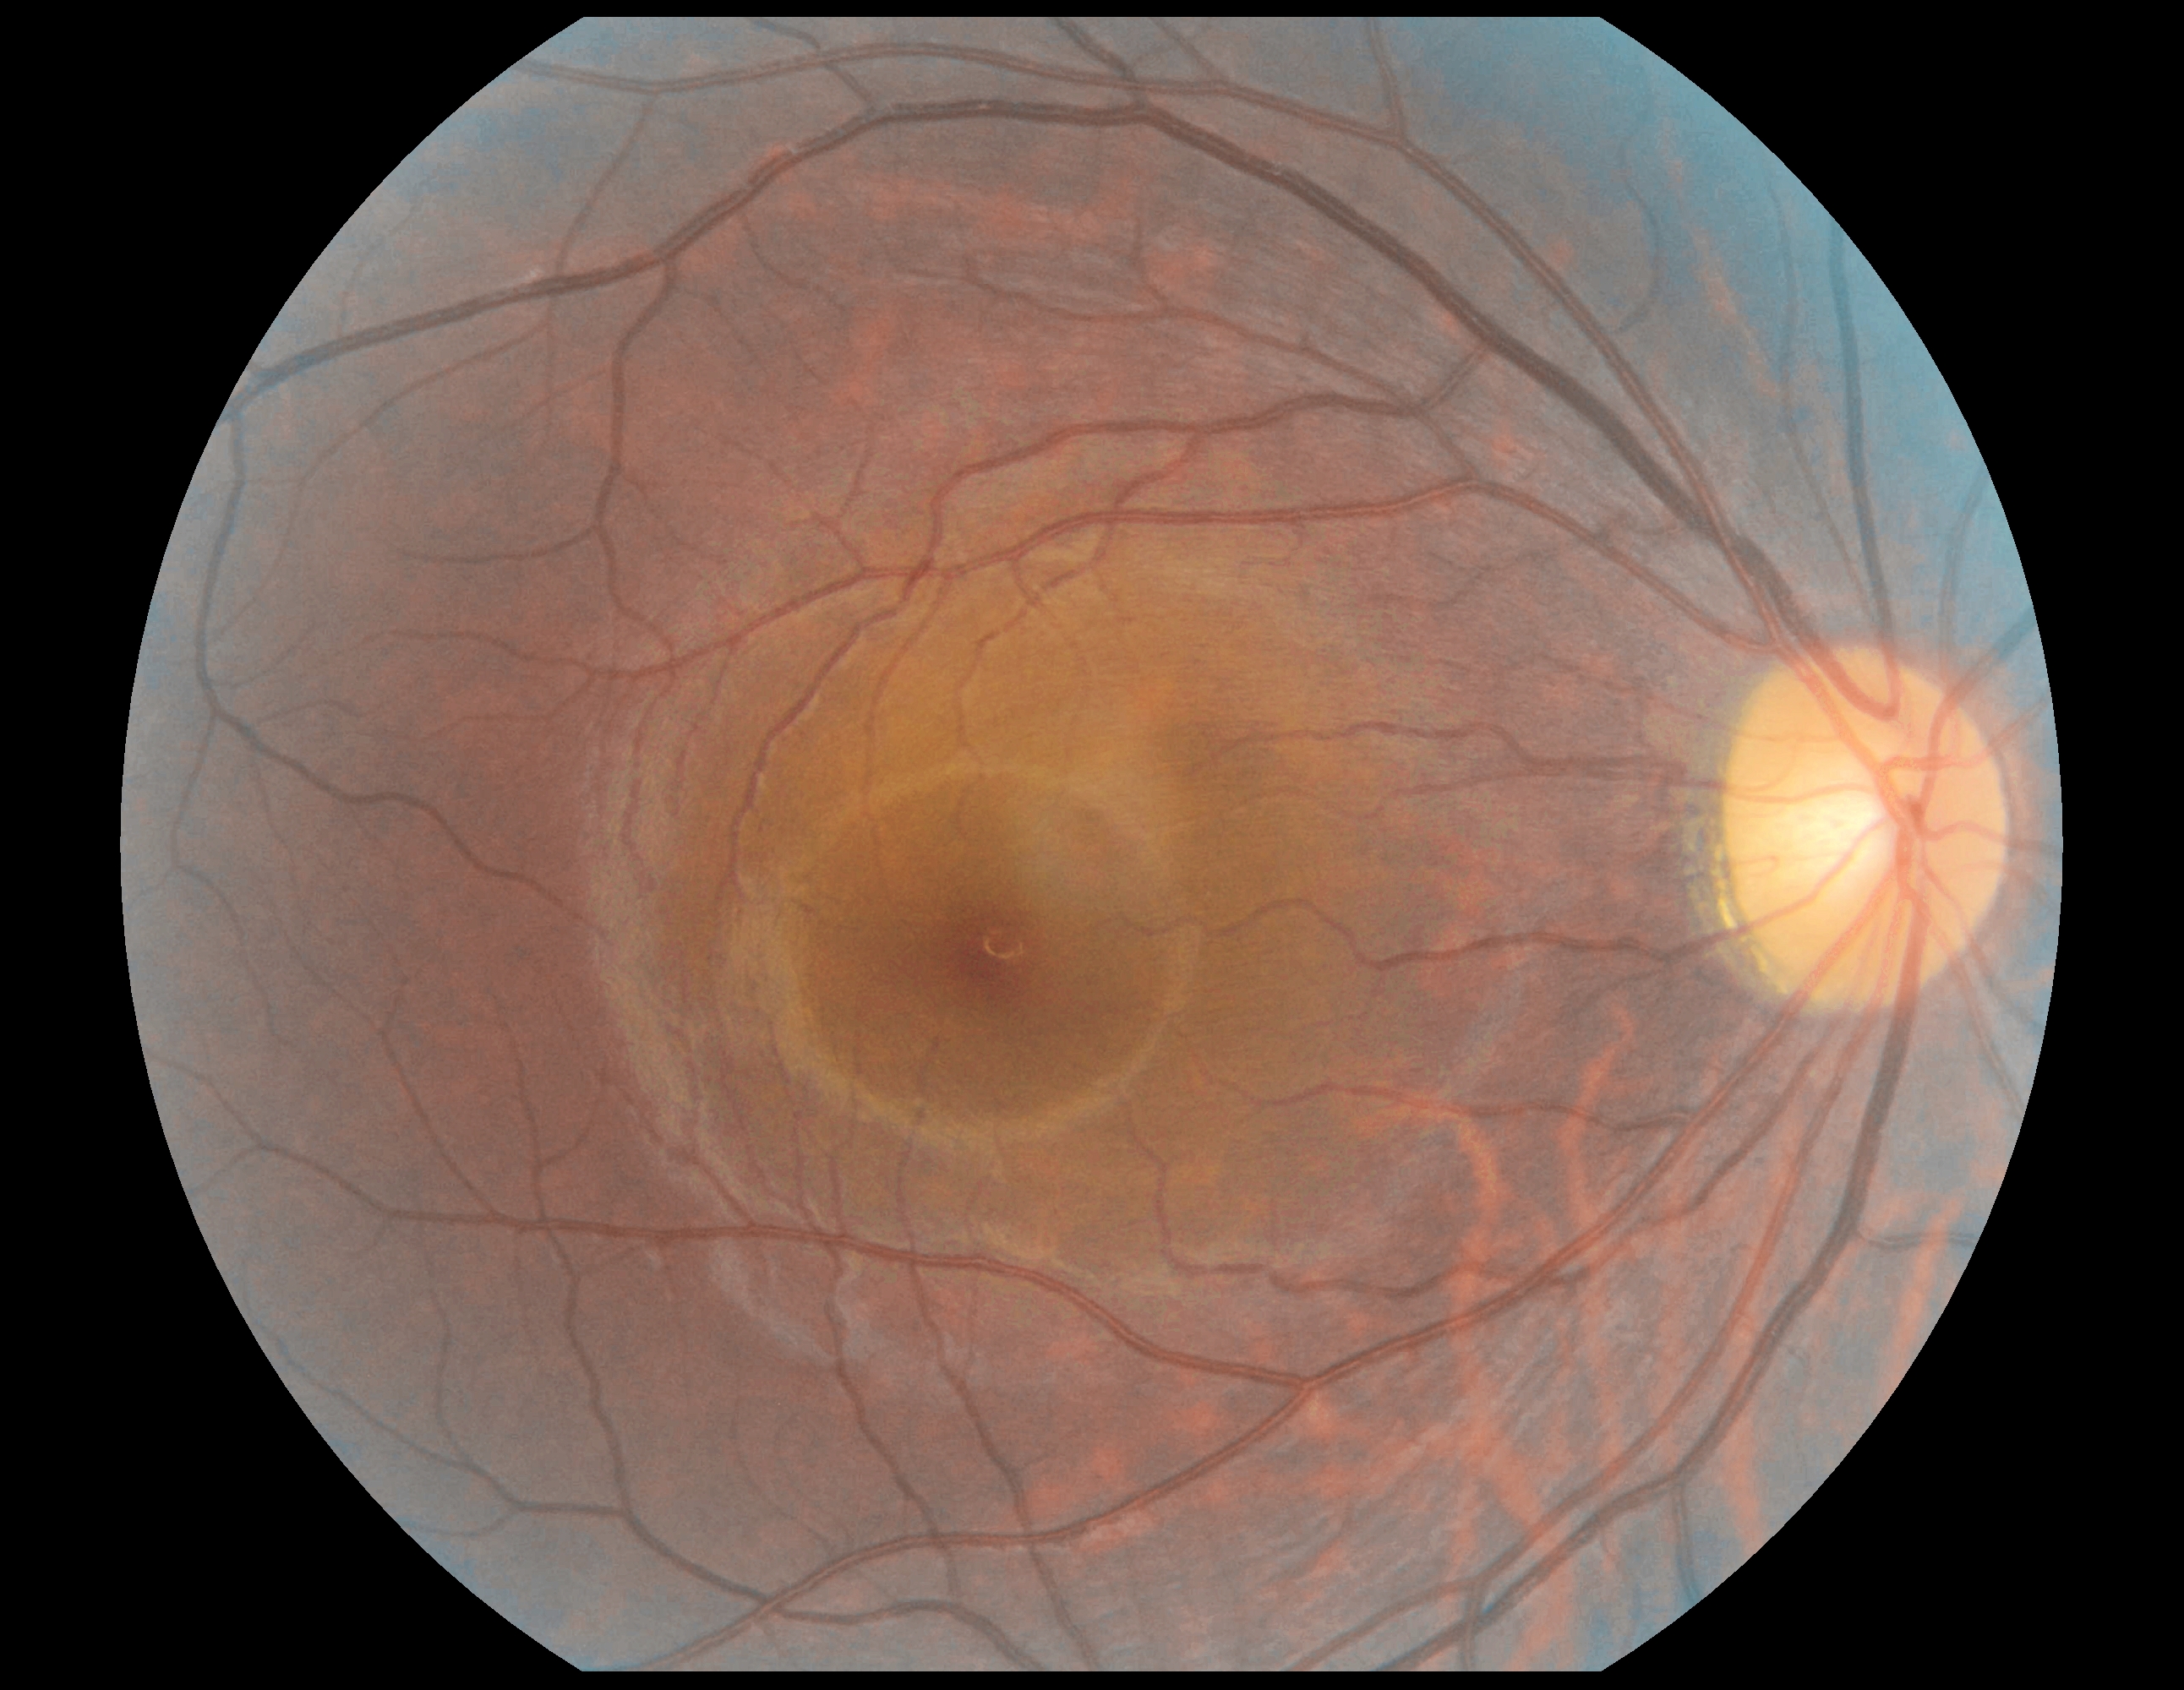
Annotations:
• diabetic retinopathy severity: grade 0 (no apparent retinopathy)